Fundus photo. FOV: 45 degrees:
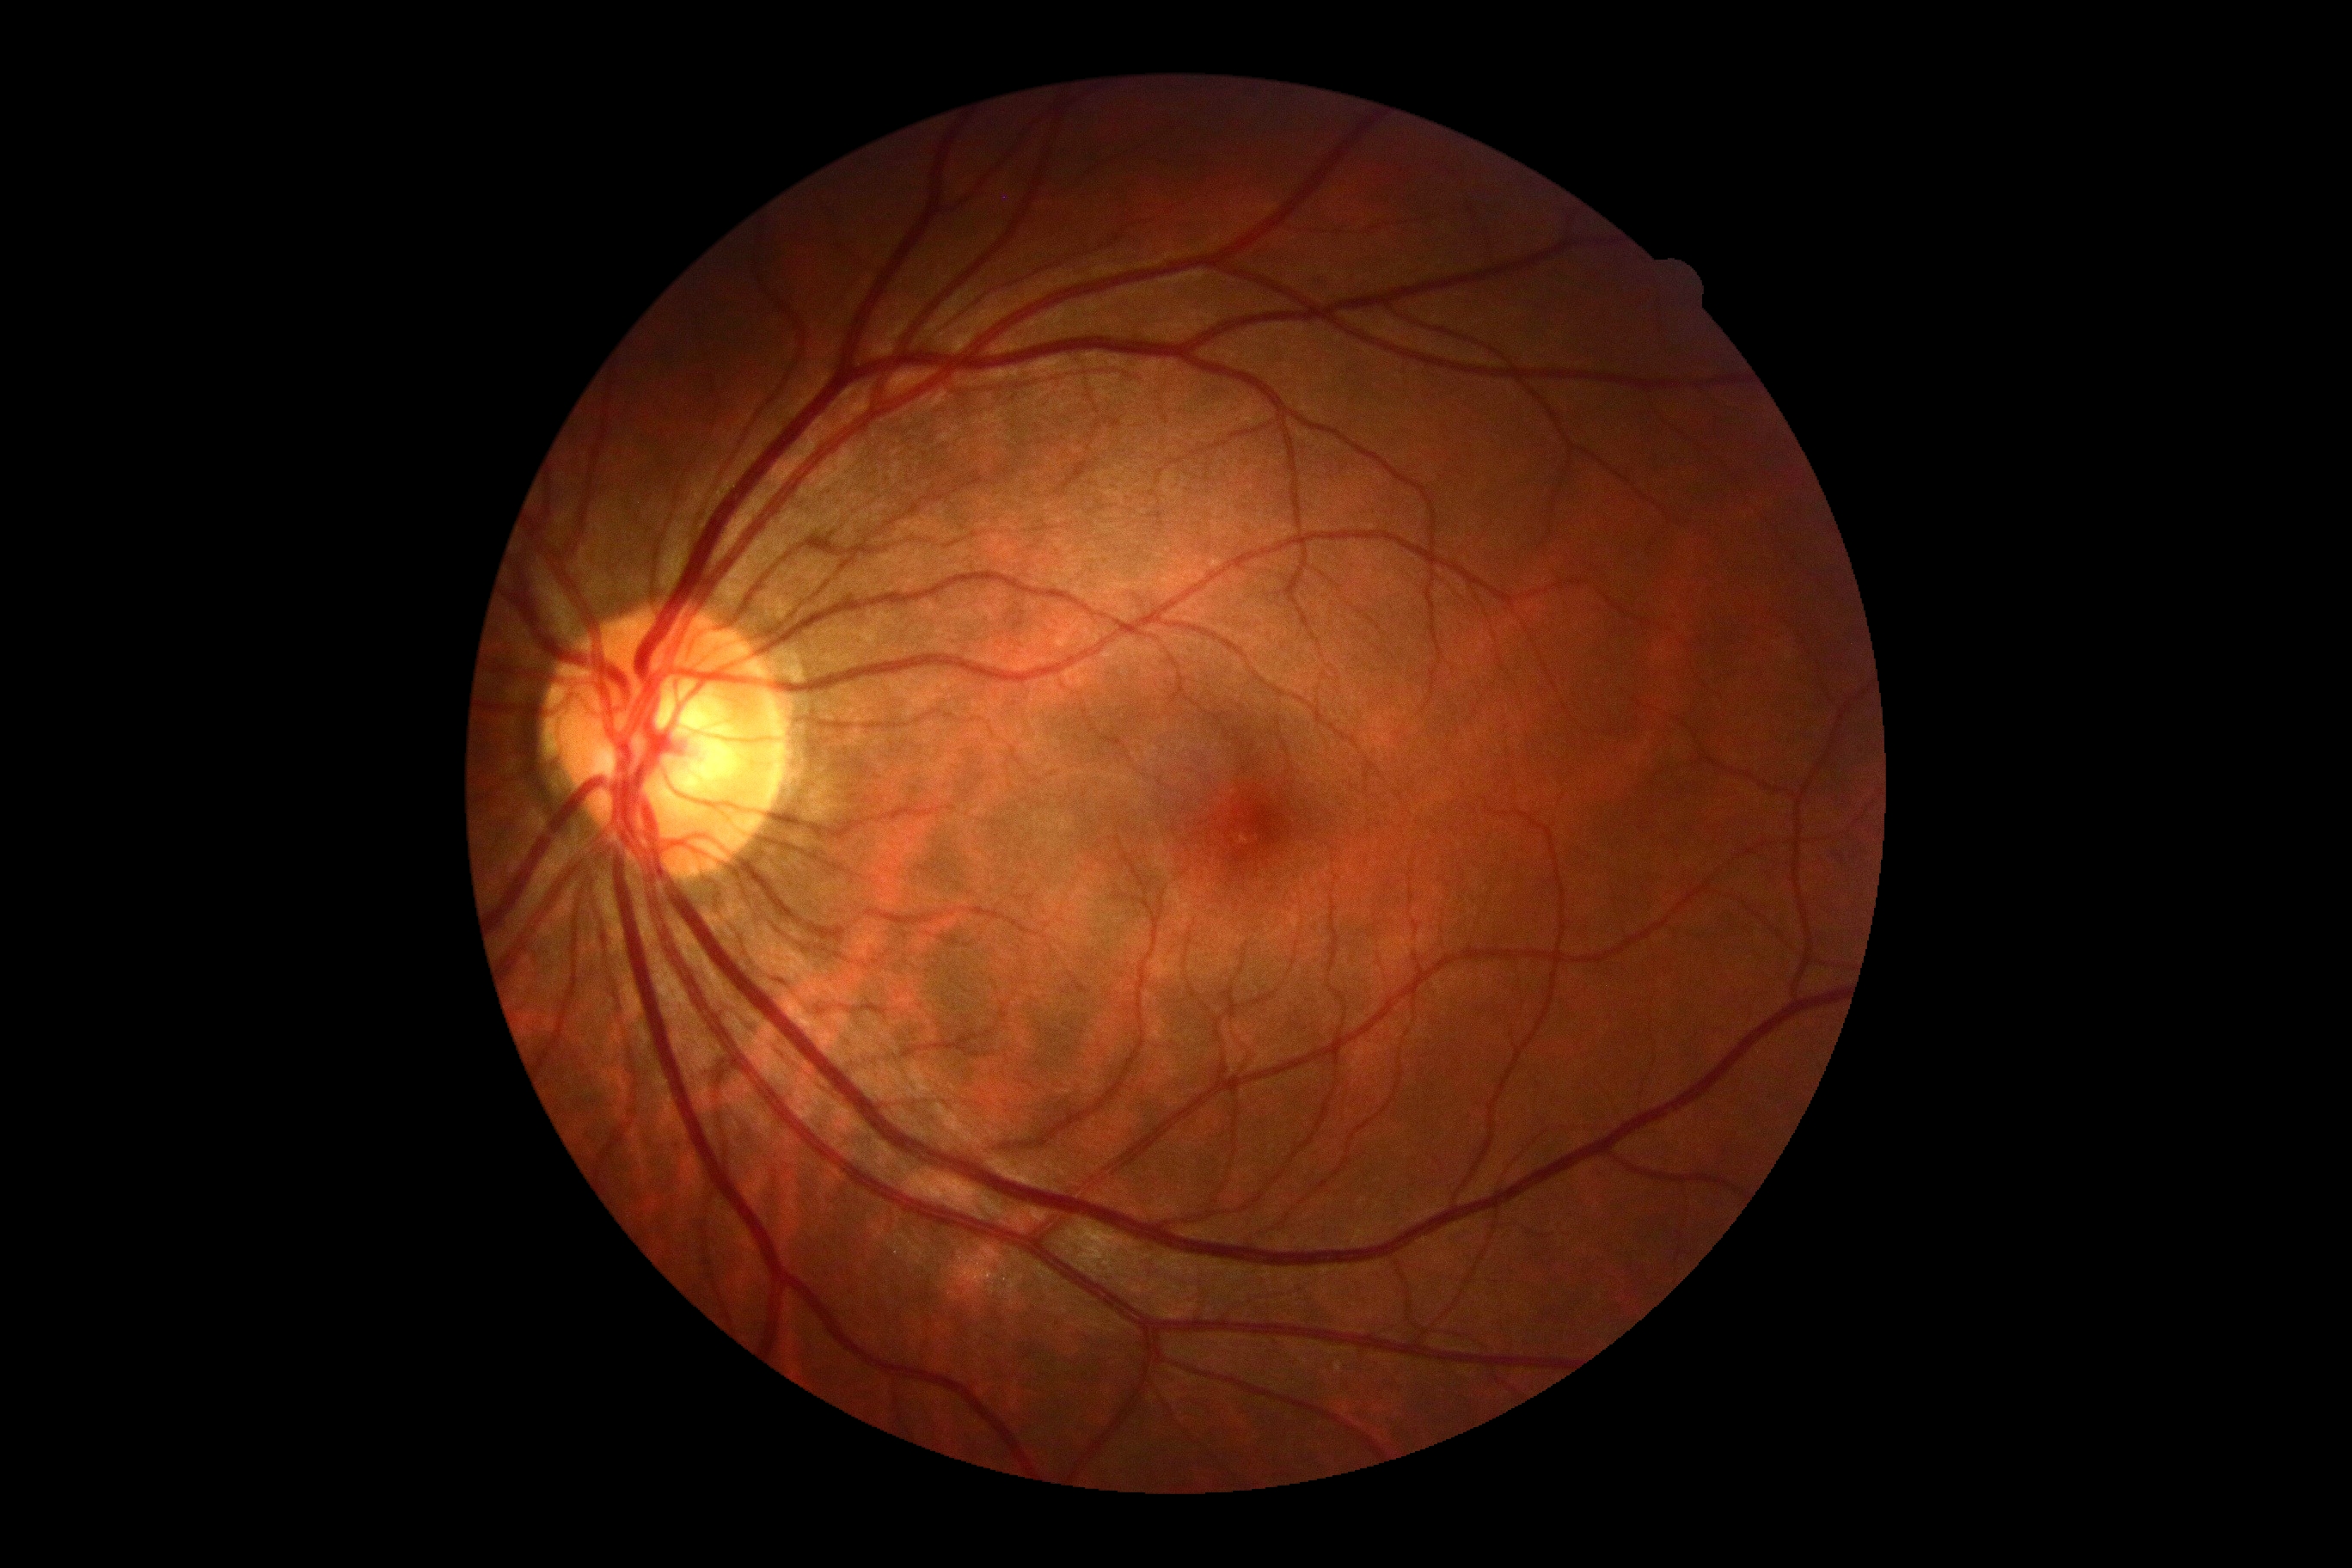 dr_grade: no apparent retinopathy (grade 0) — no visible signs of diabetic retinopathy
dr_impression: no DR findings